FOV: 45 degrees, posterior pole color fundus photograph, NIDEK AFC-230 fundus camera, 848x848px:
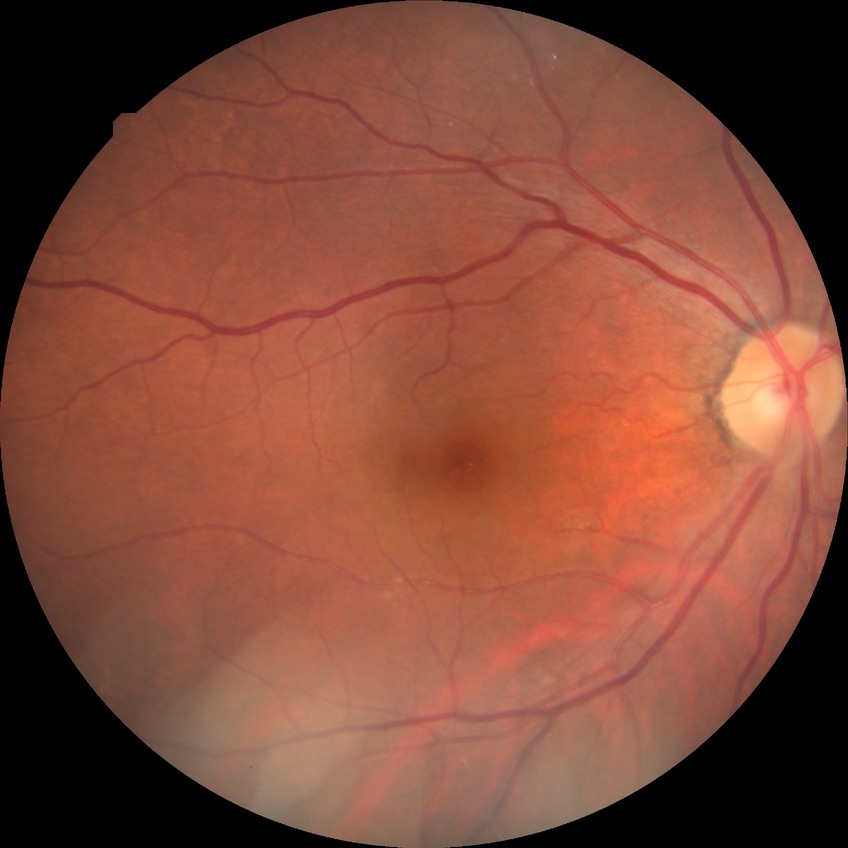

DR grade is NDR. No diabetic retinal disease findings.